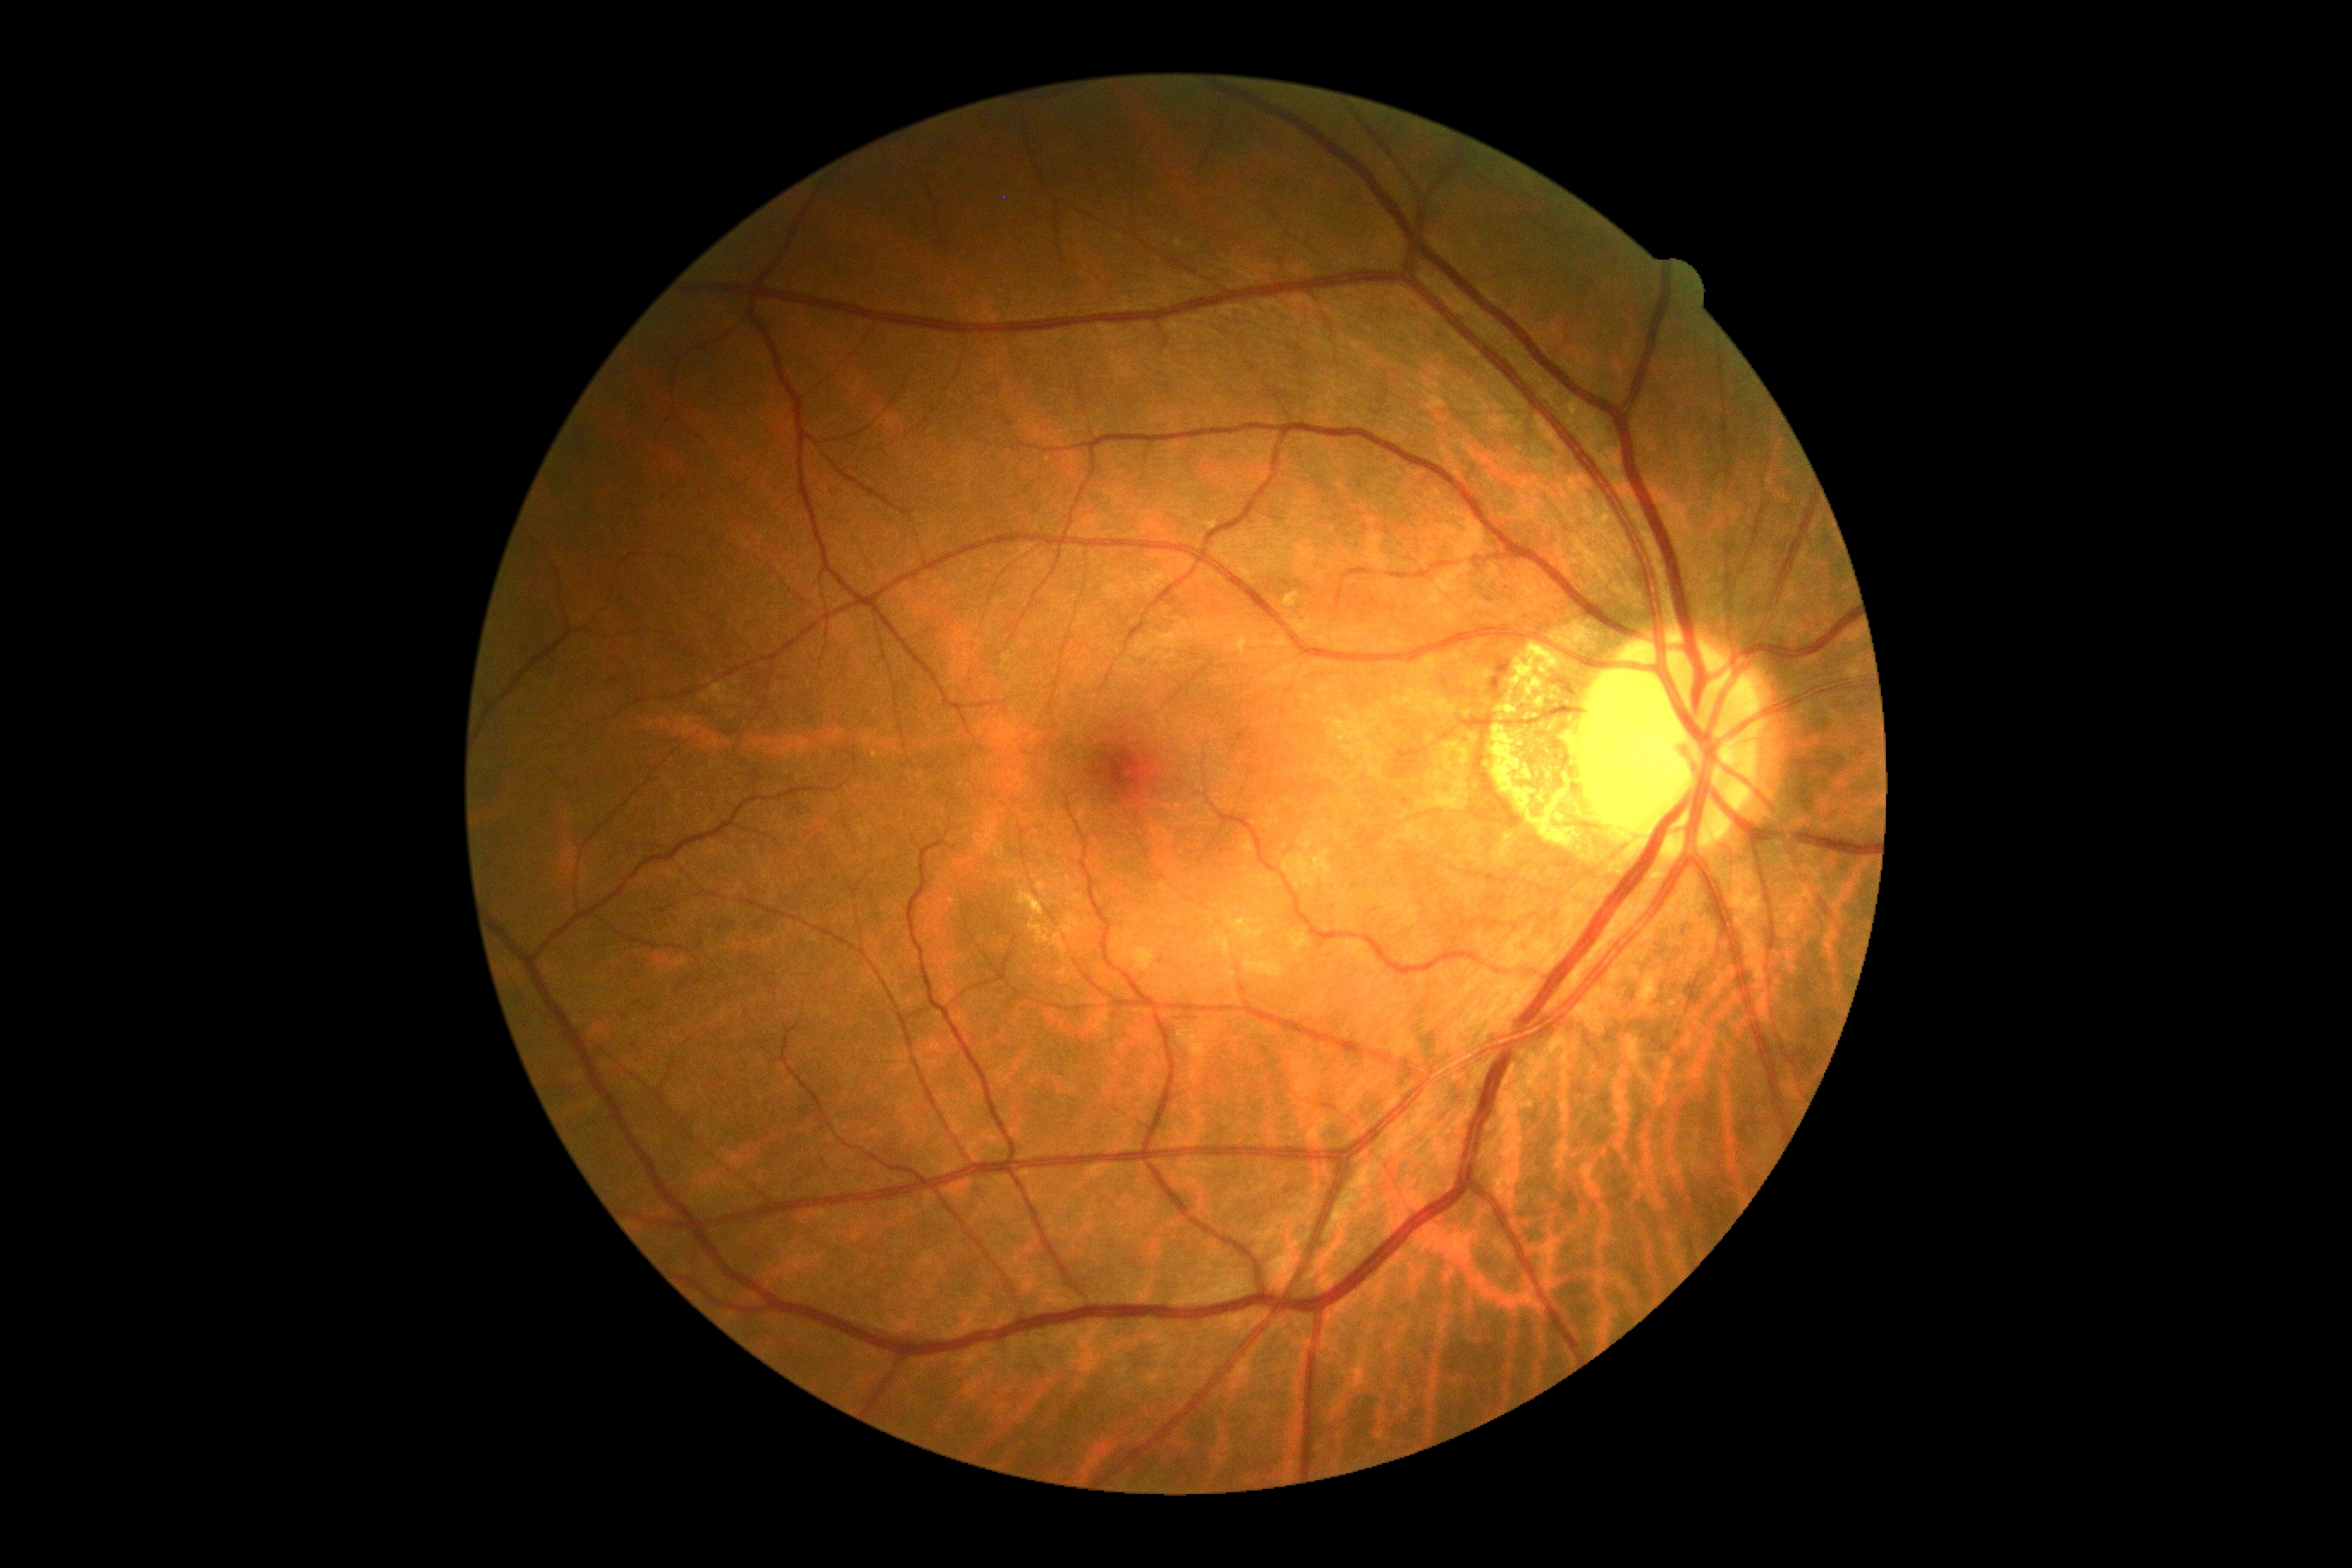

DR severity: grade 0.